Without pupil dilation: 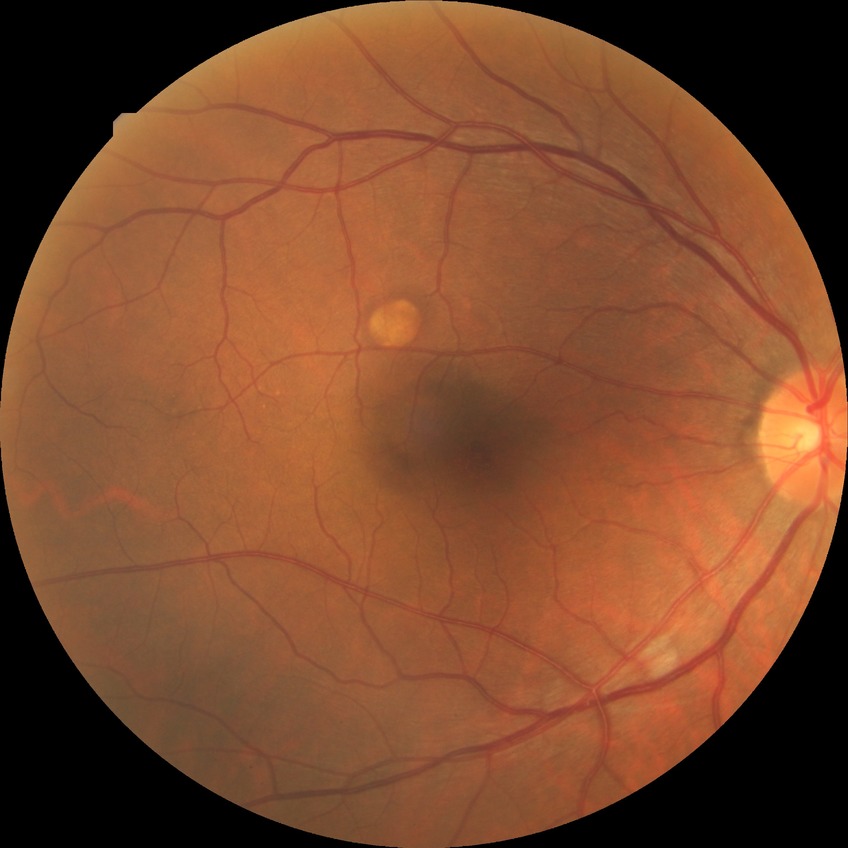
No signs of diabetic retinopathy.
DR grade: NDR.